Color fundus photograph:
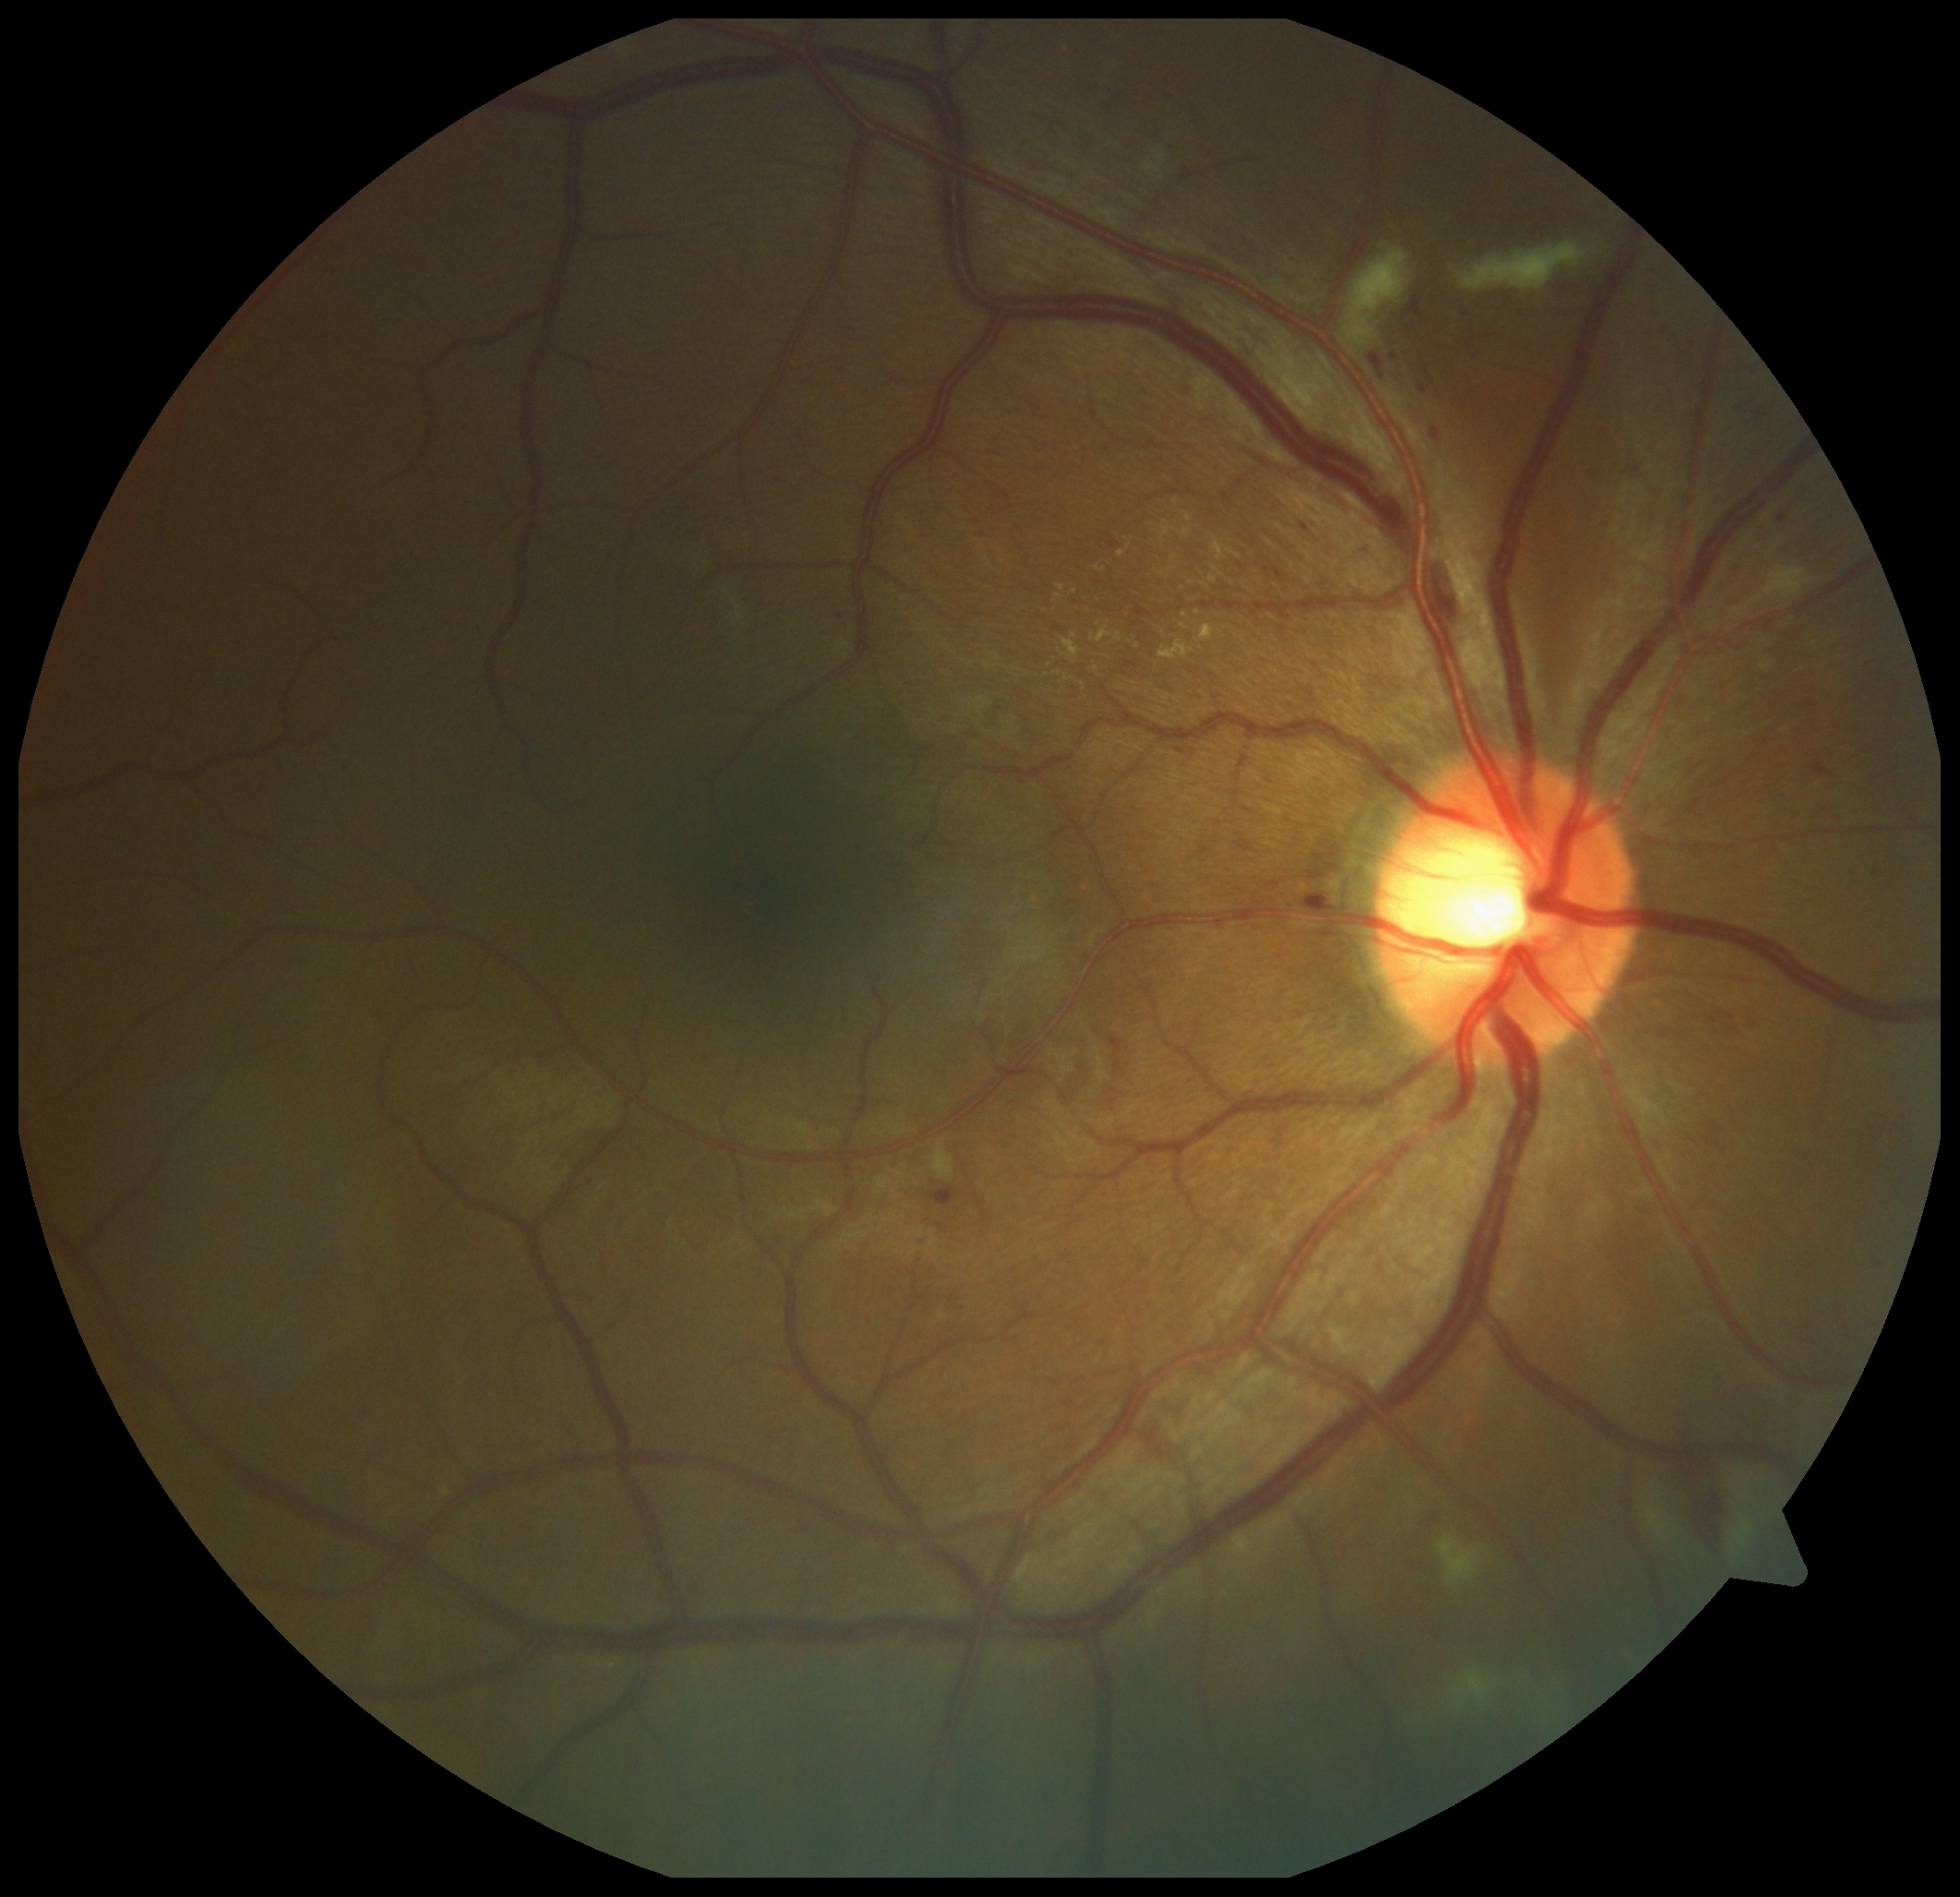
partial: true
dr_grade: 2
lesions:
  ex:
    - 1213 542 1224 562
    - 1160 641 1196 660
    - 1058 585 1066 592
    - 1209 575 1218 585
    - 1180 624 1188 632
    - 1200 624 1216 643
  ex_small_approx:
    - x=1097, y=670
    - x=1100, y=624
    - x=1192, y=584
    - x=1176, y=502
    - x=1058, y=597
    - x=1163, y=542
  ma:
    - 1655 1144 1664 1151
    - 1729 1026 1740 1035
    - 1755 408 1767 420
    - 1708 1017 1720 1026
    - 1419 384 1430 395
    - 1370 353 1385 380
    - 1107 534 1120 549
    - 1391 353 1399 362
    - 1109 1037 1122 1050
    - 1874 870 1882 877
    - 1410 295 1428 324
  ma_small_approx:
    - x=591, y=1183
    - x=1306, y=528
    - x=1367, y=551
    - x=1126, y=1049